640x480 · acquired on the Clarity RetCam 3 · RetCam wide-field infant fundus image: 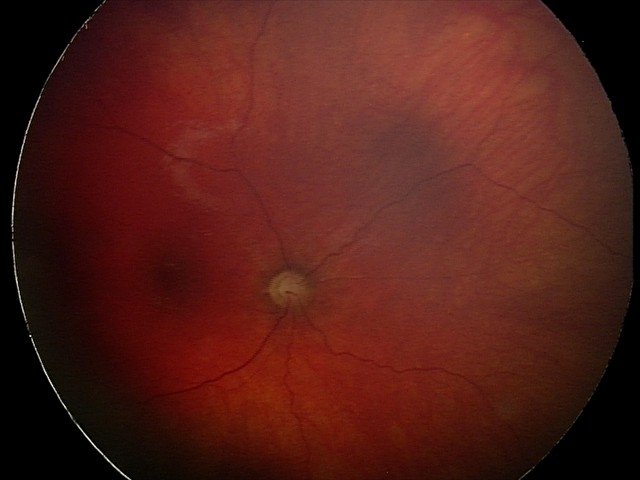

Screening series with optic nerve hypoplasia.